45° FOV. Color fundus image. 2352x1568px
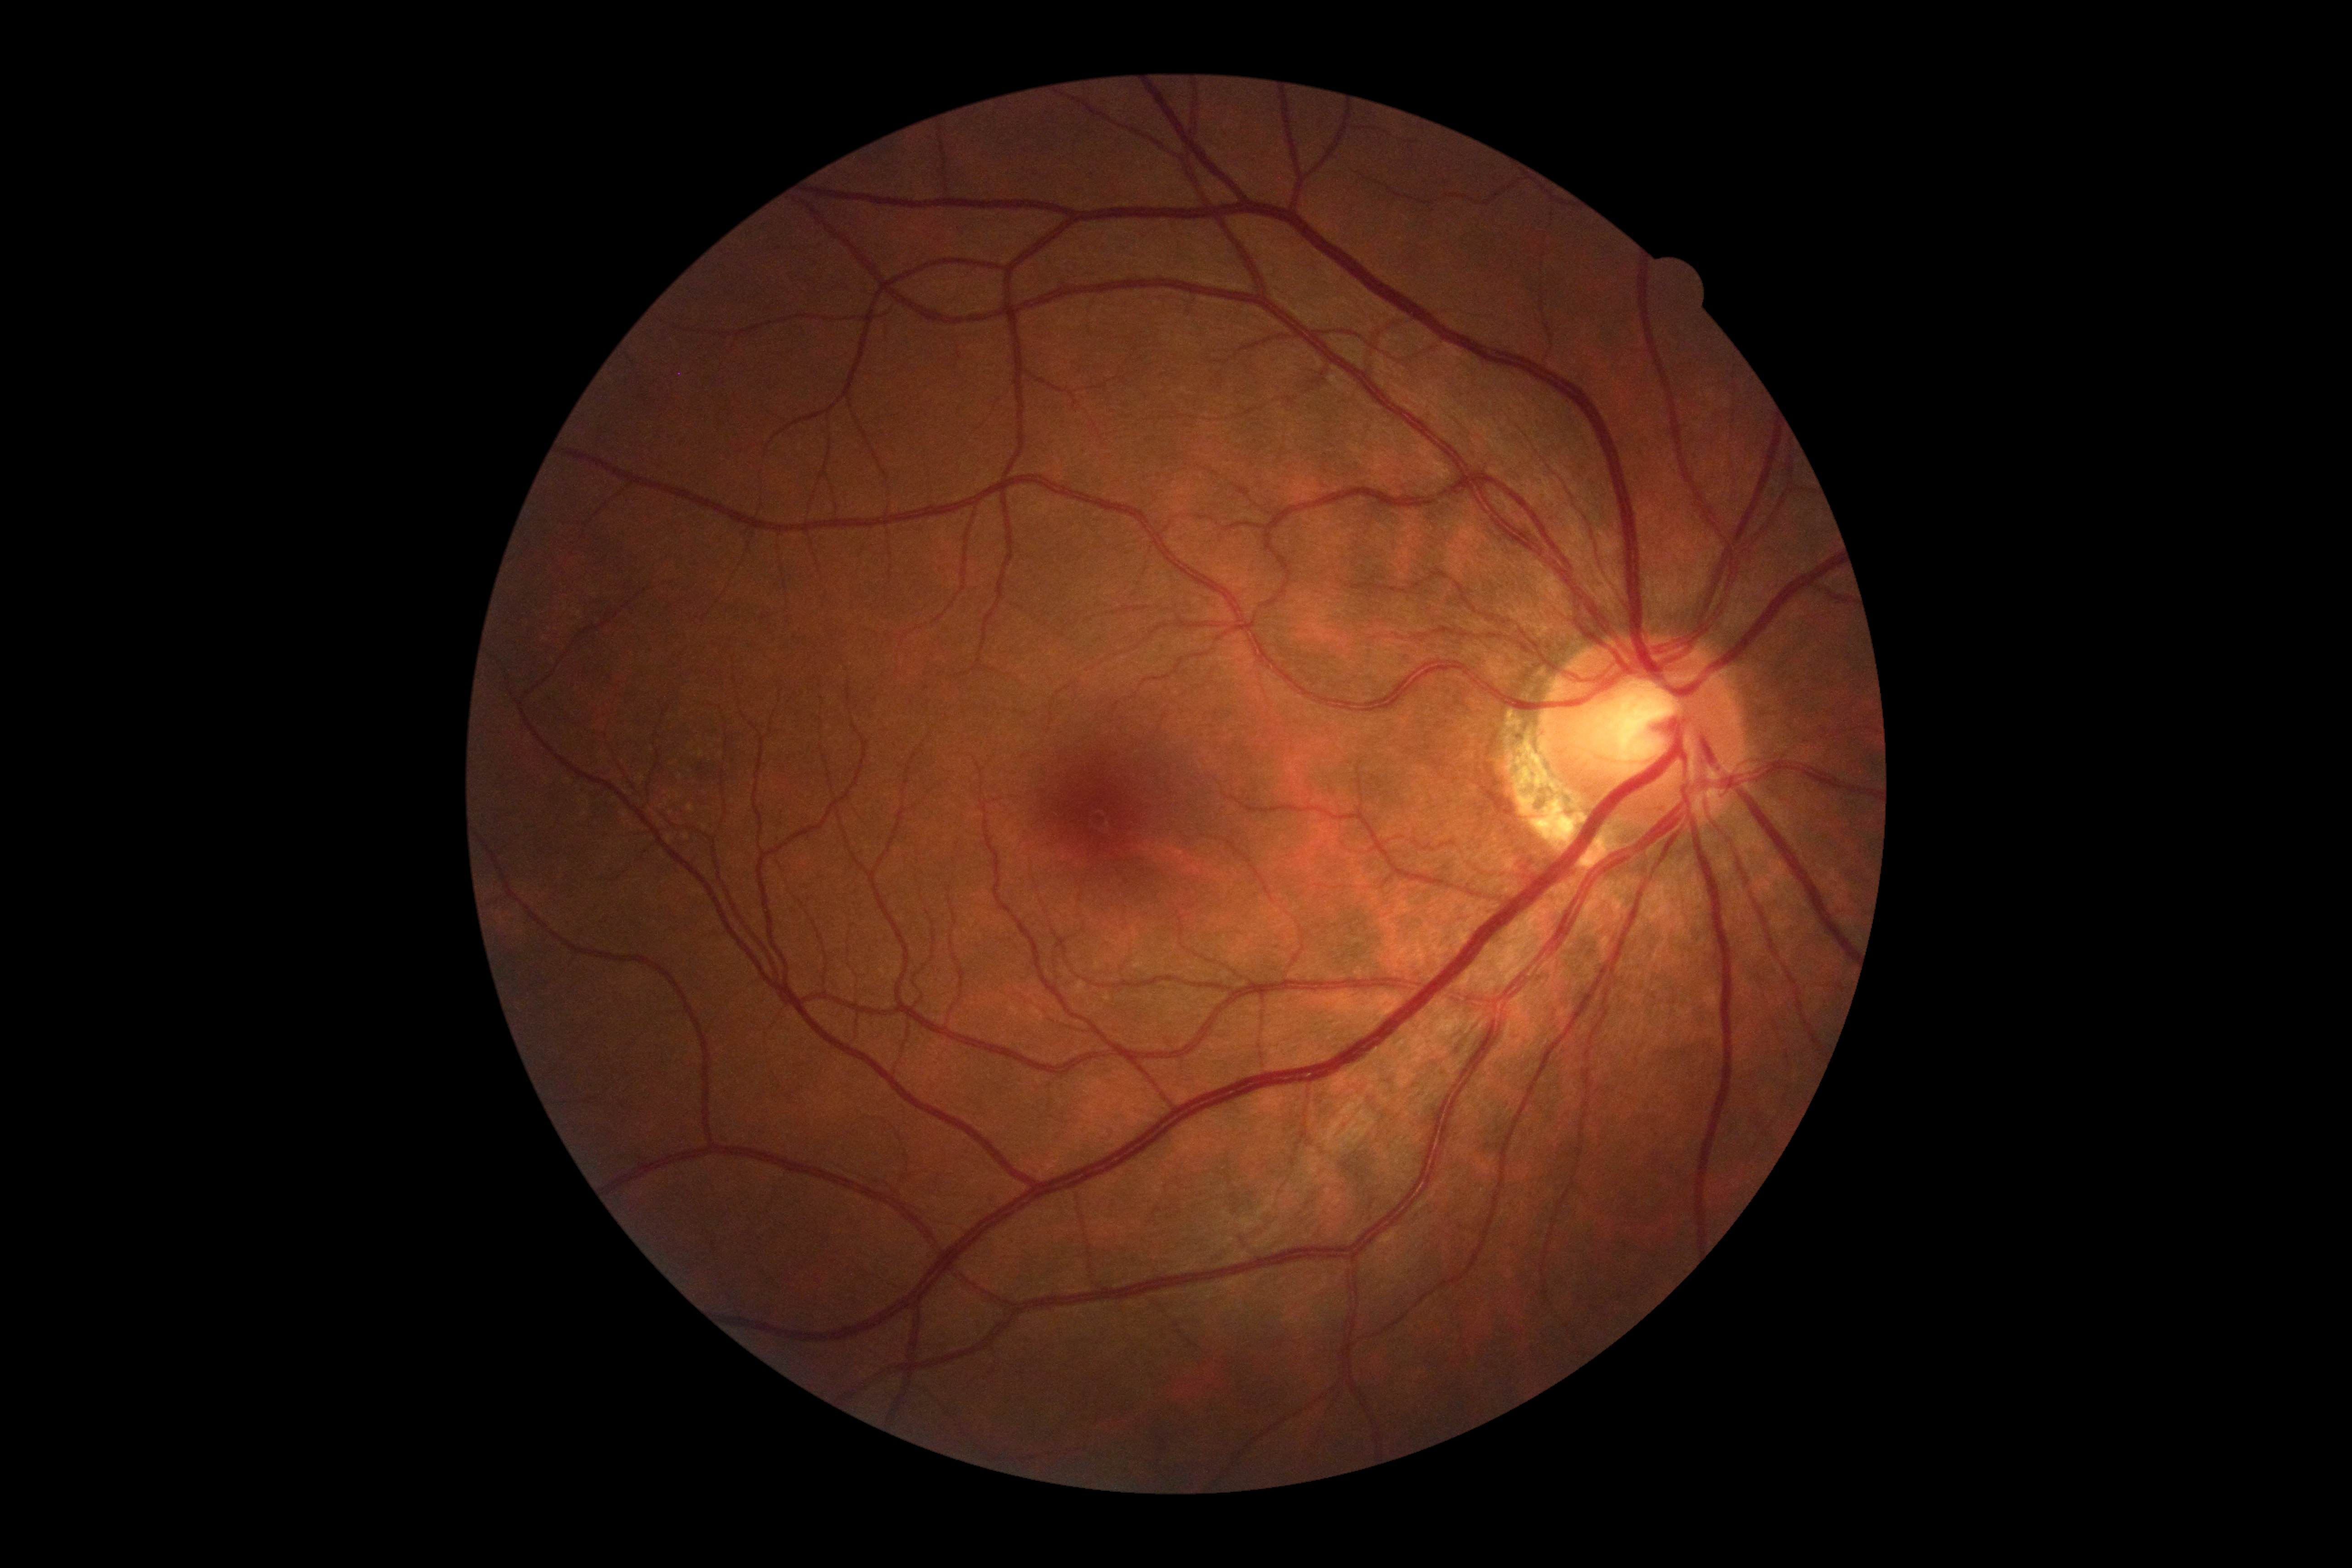

Diabetic retinopathy severity: grade 0.